Pediatric retinal photograph (wide-field)
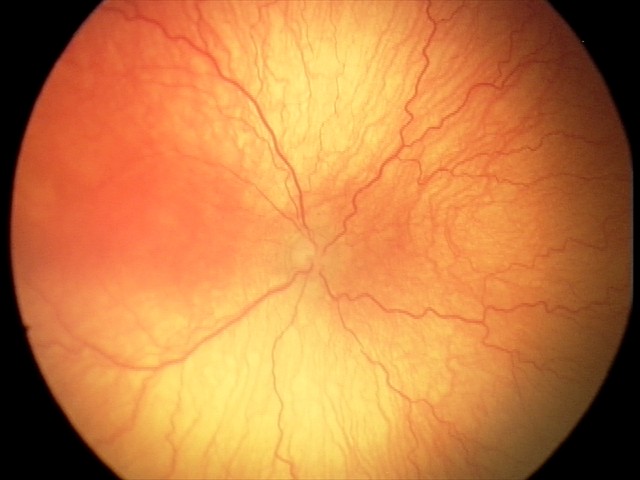

Plus disease was diagnosed. From an examination with diagnosis of aggressive retinopathy of prematurity.